RetCam wide-field infant fundus image · camera: Natus RetCam Envision (130° FOV) — 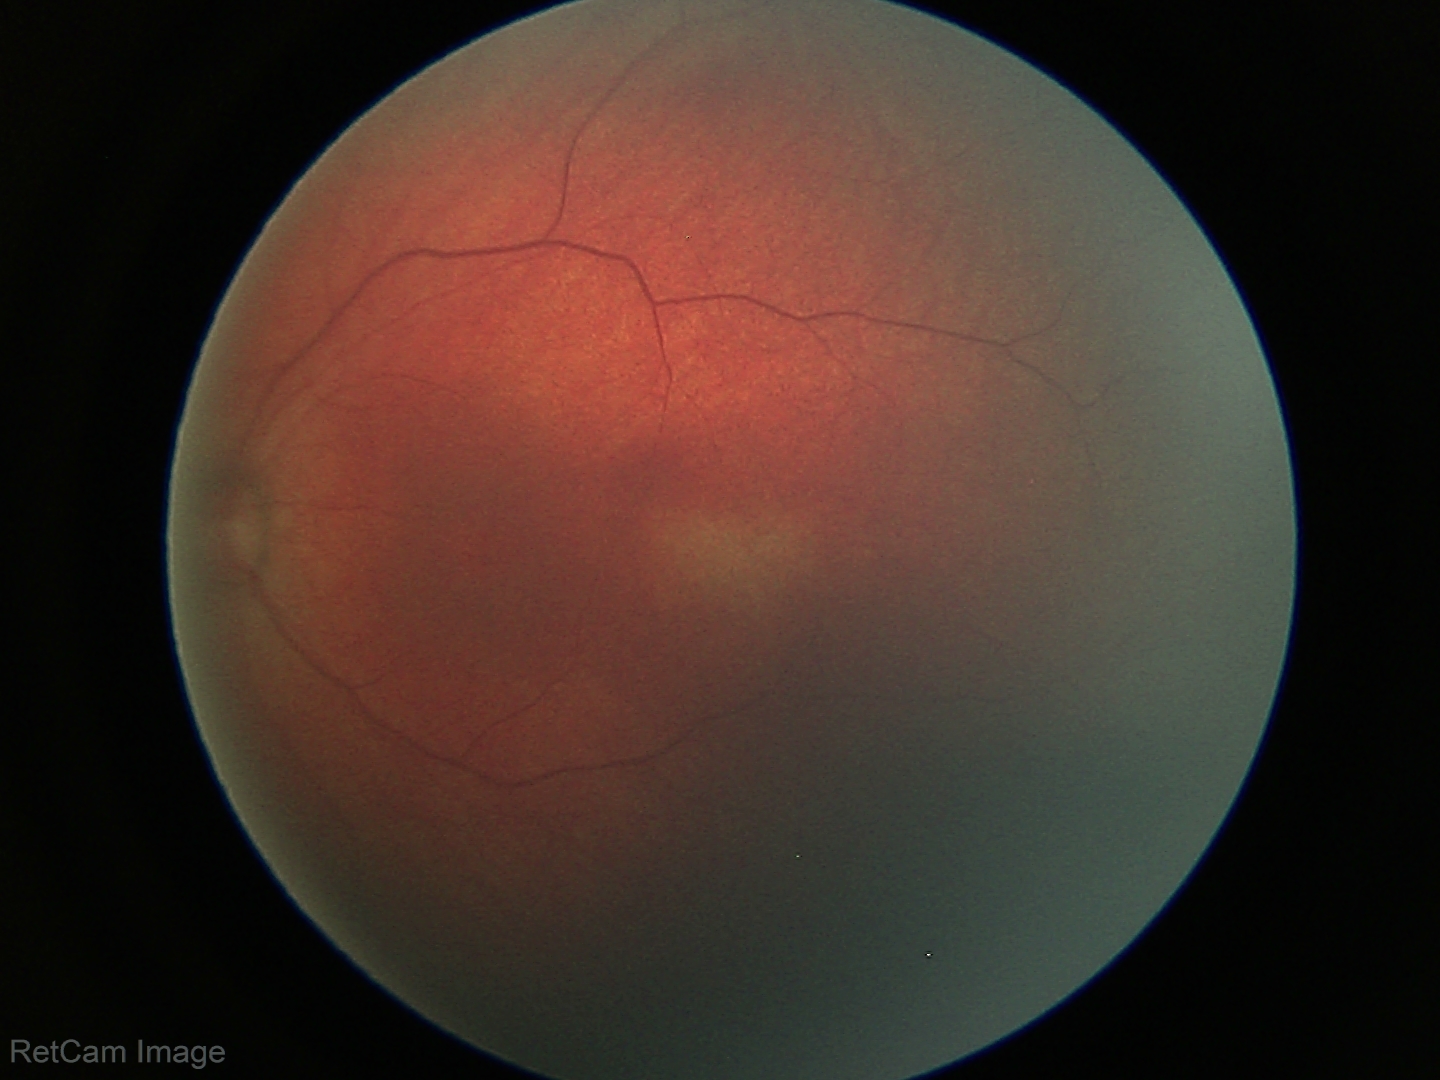 Screening examination diagnosed as physiological.